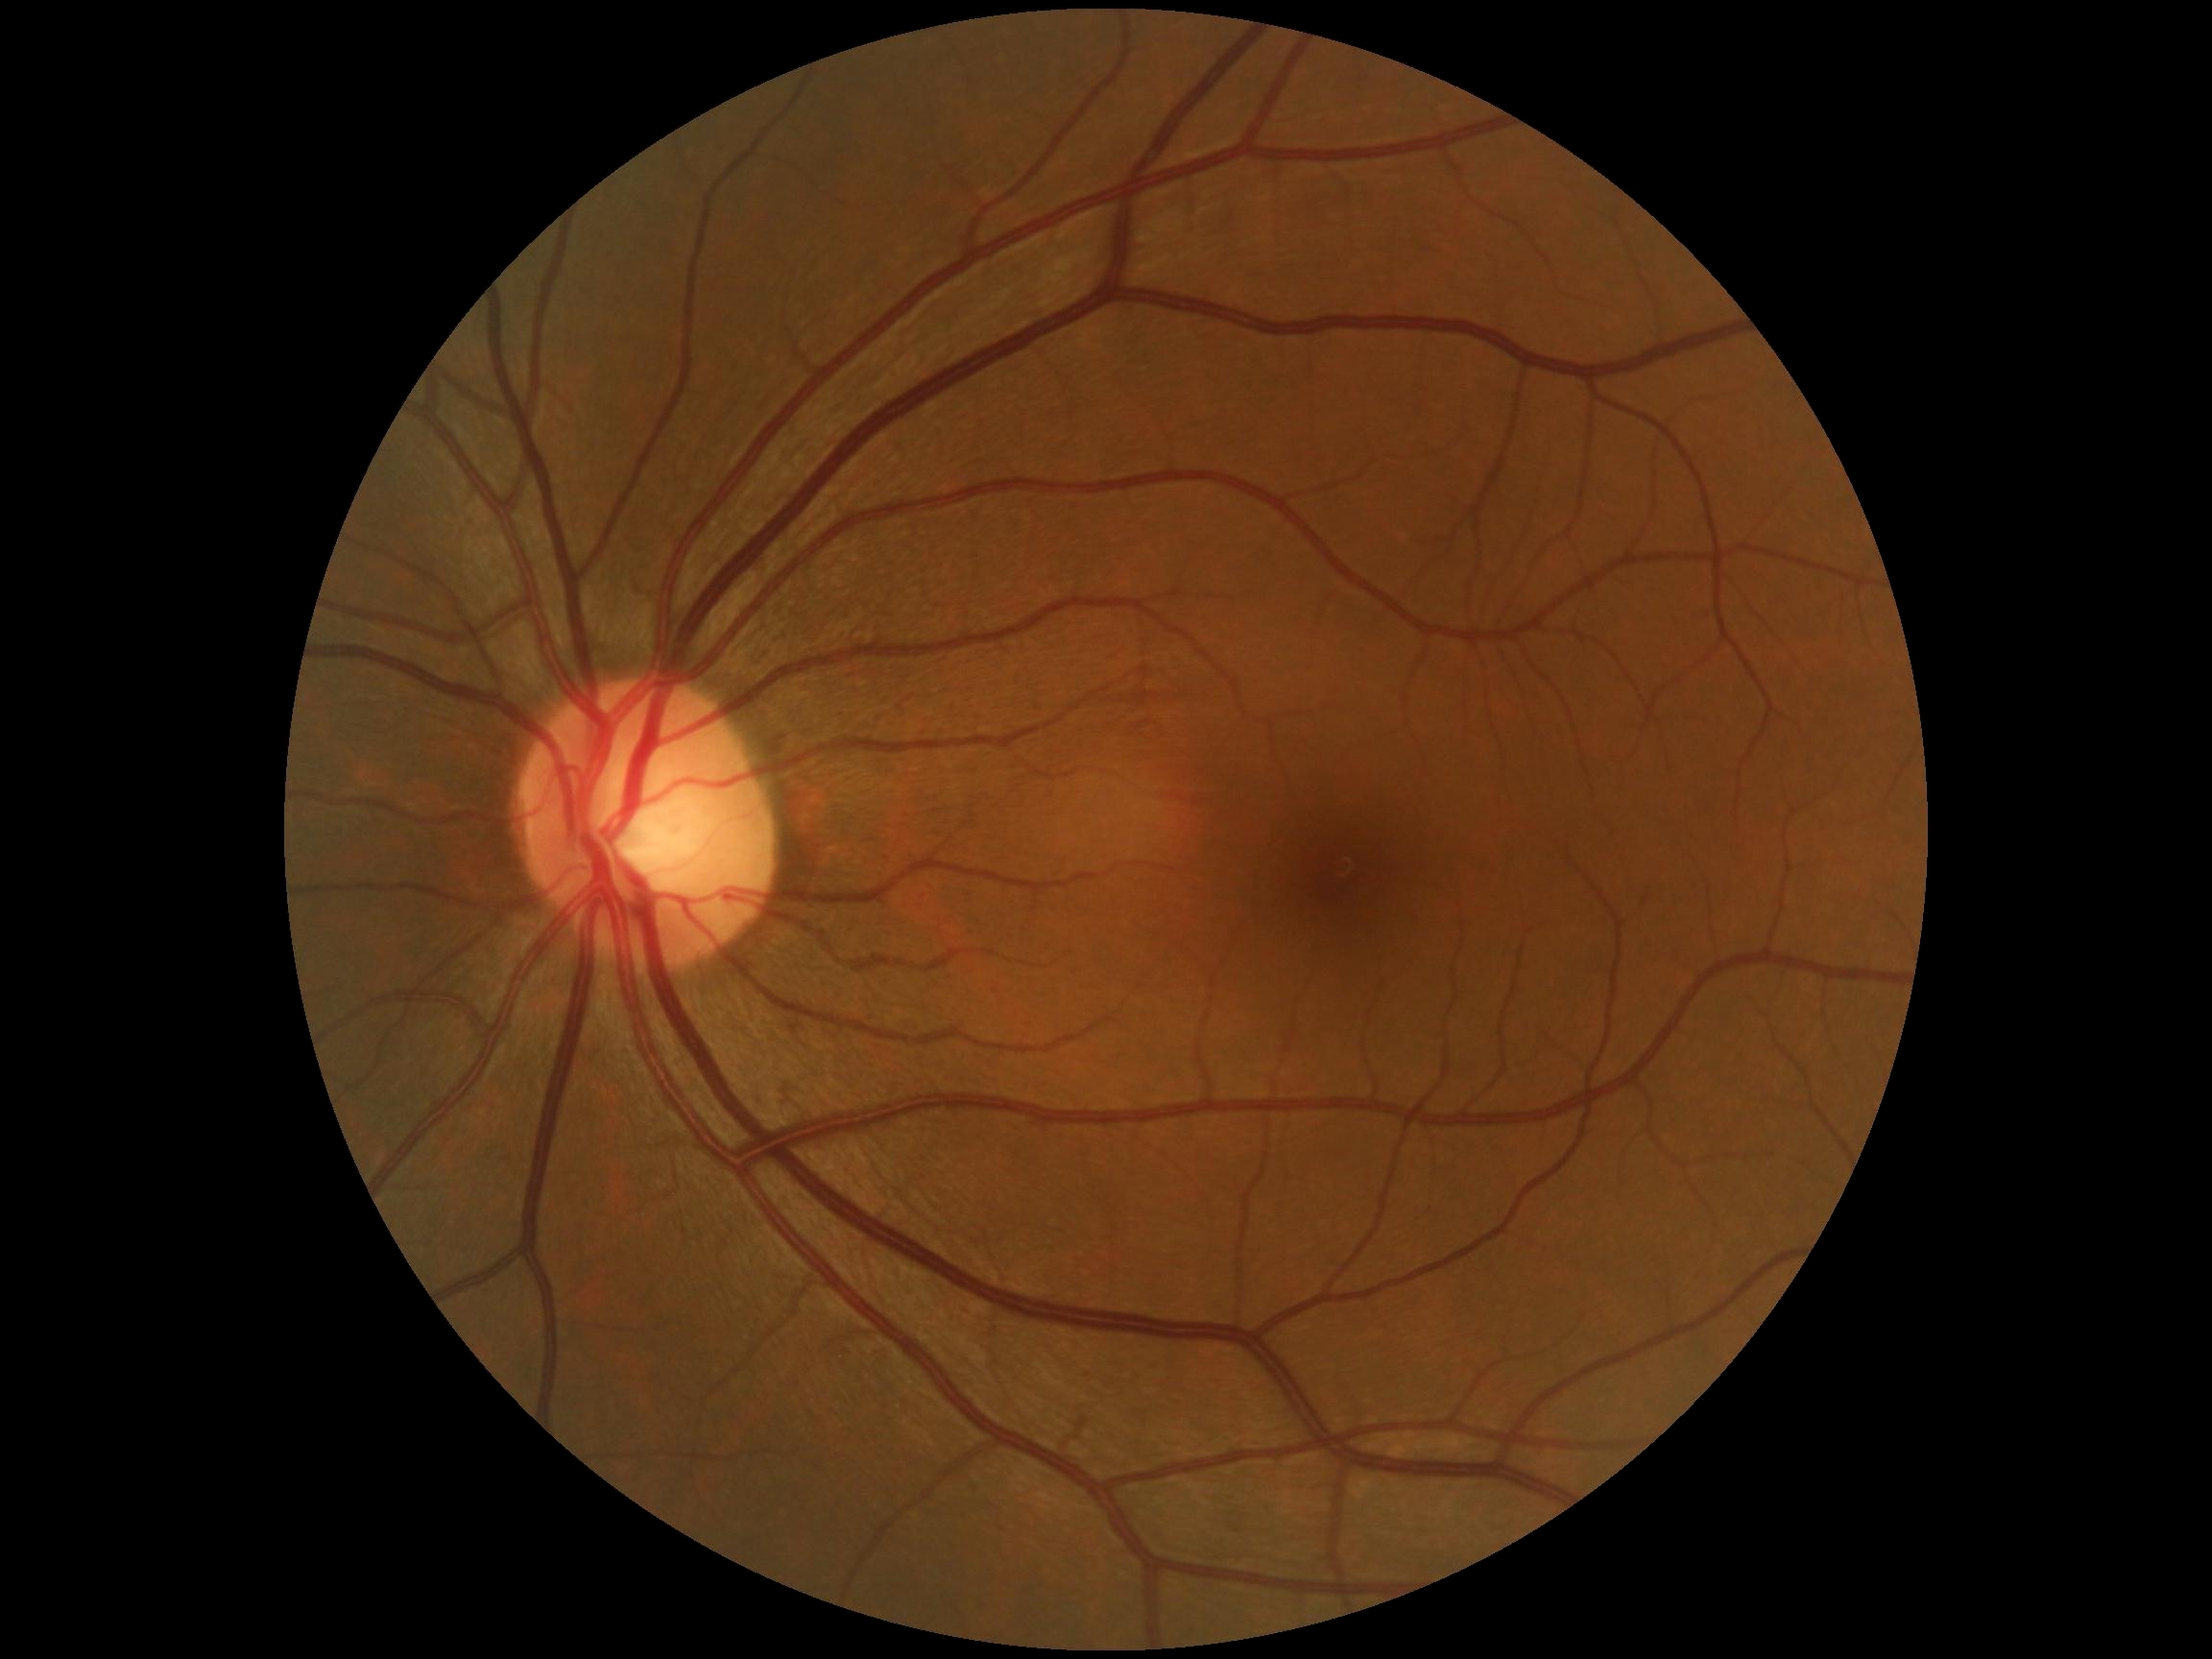

Diabetic retinopathy (DR): grade 0 (no apparent retinopathy) — no visible signs of diabetic retinopathy.